UWF retinal mosaic
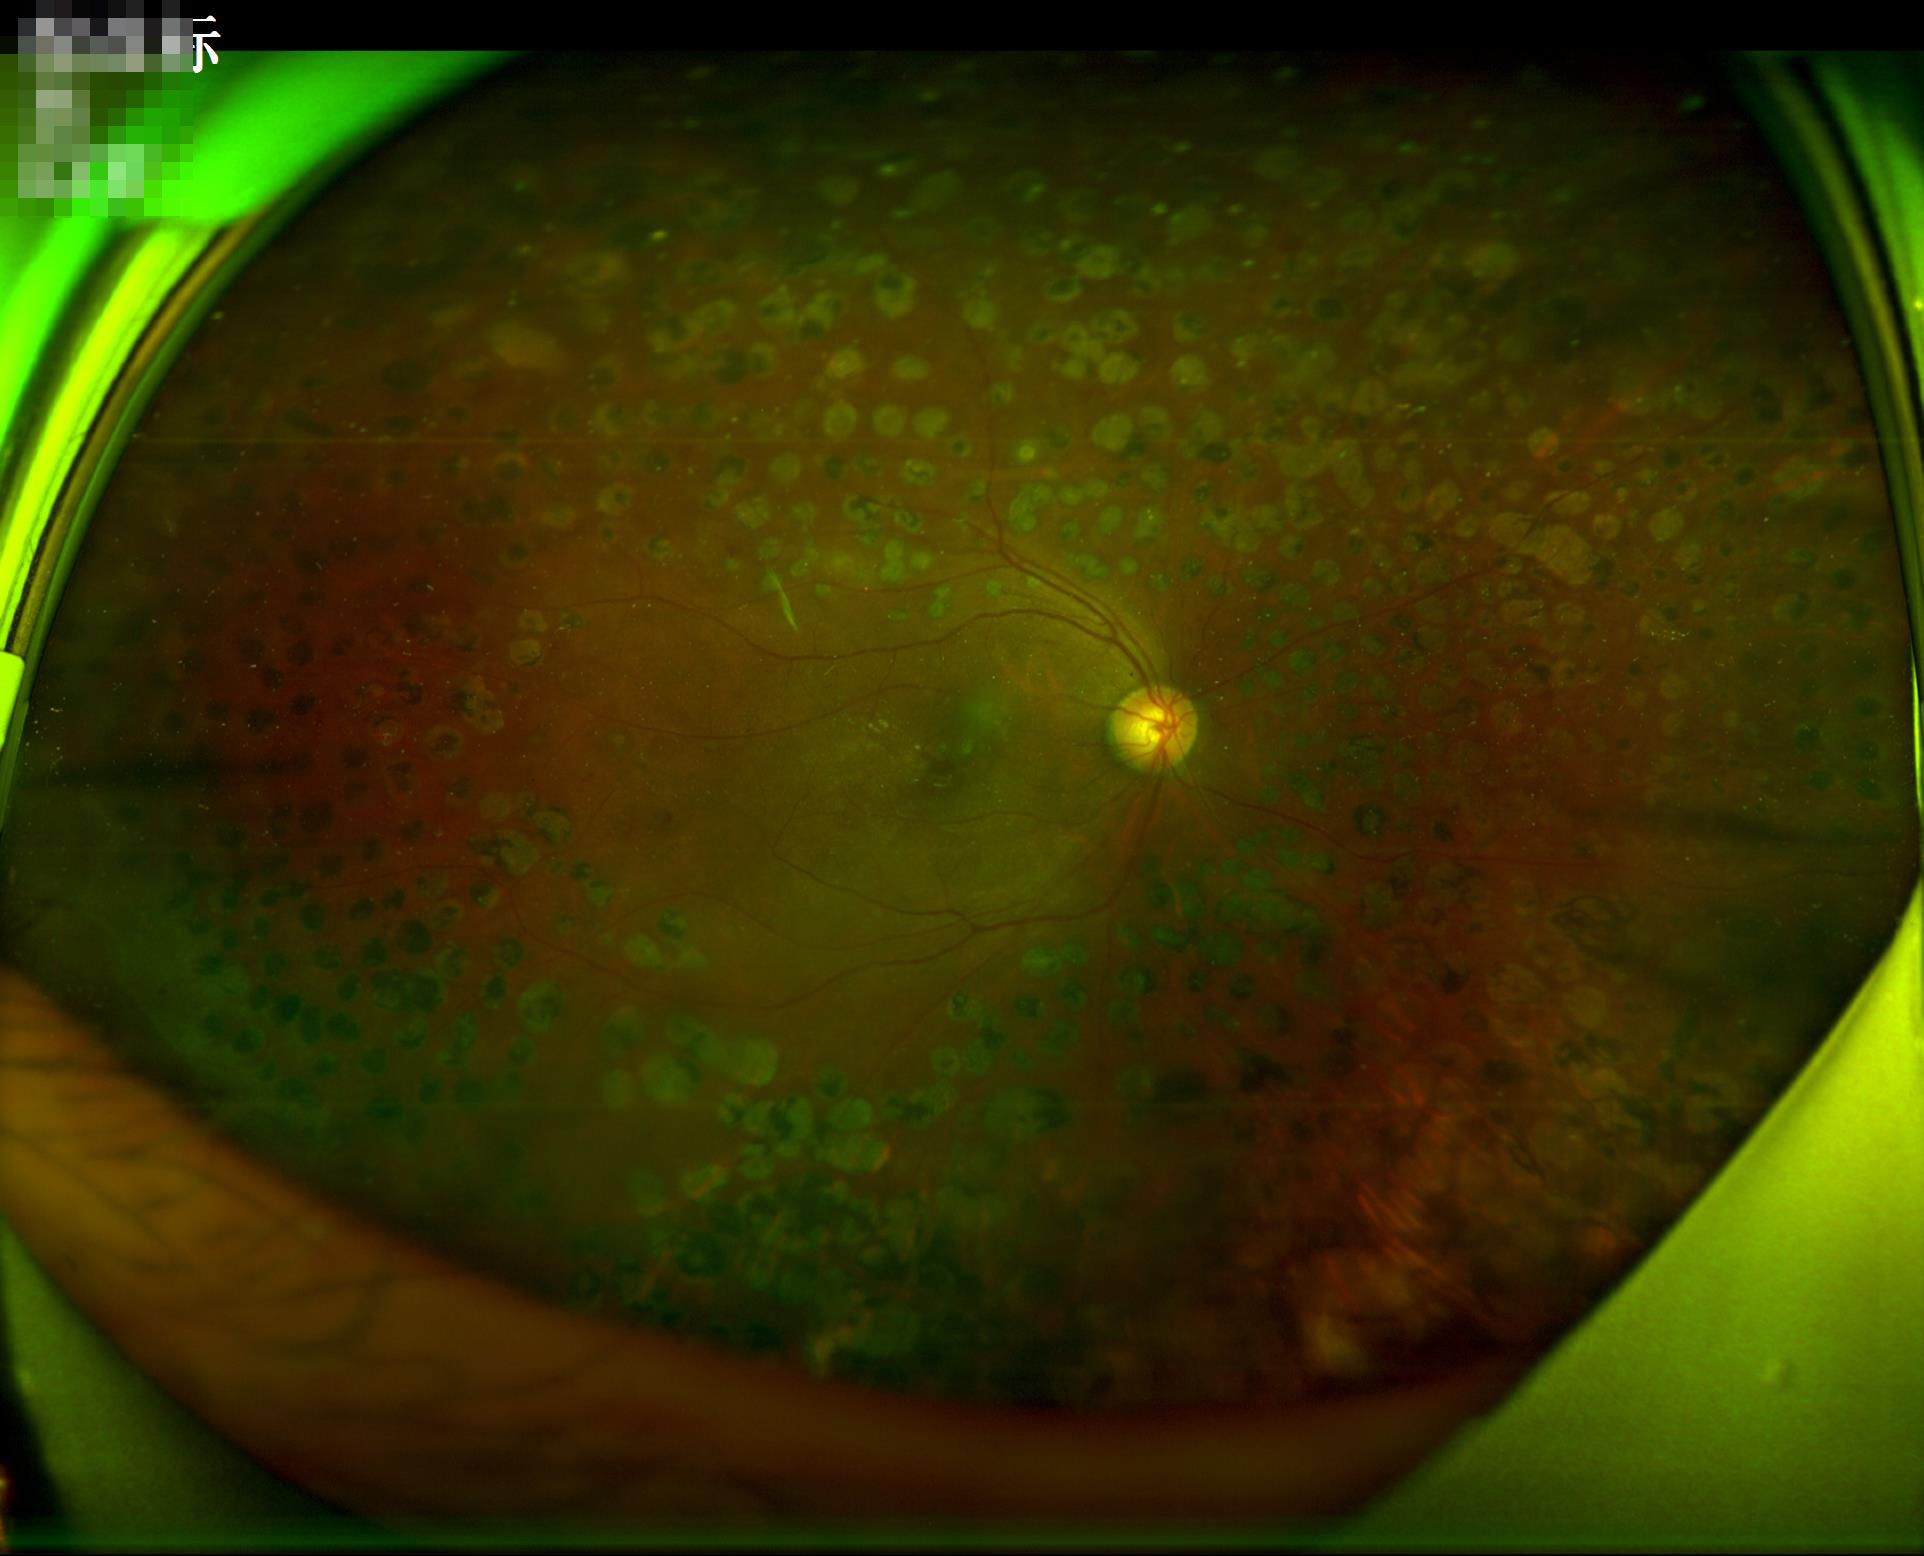

Illumination and color are suboptimal.
Optic disc, vessels, and background are in focus.
Good dynamic range.
Overall image quality is good.